Infant wide-field retinal image
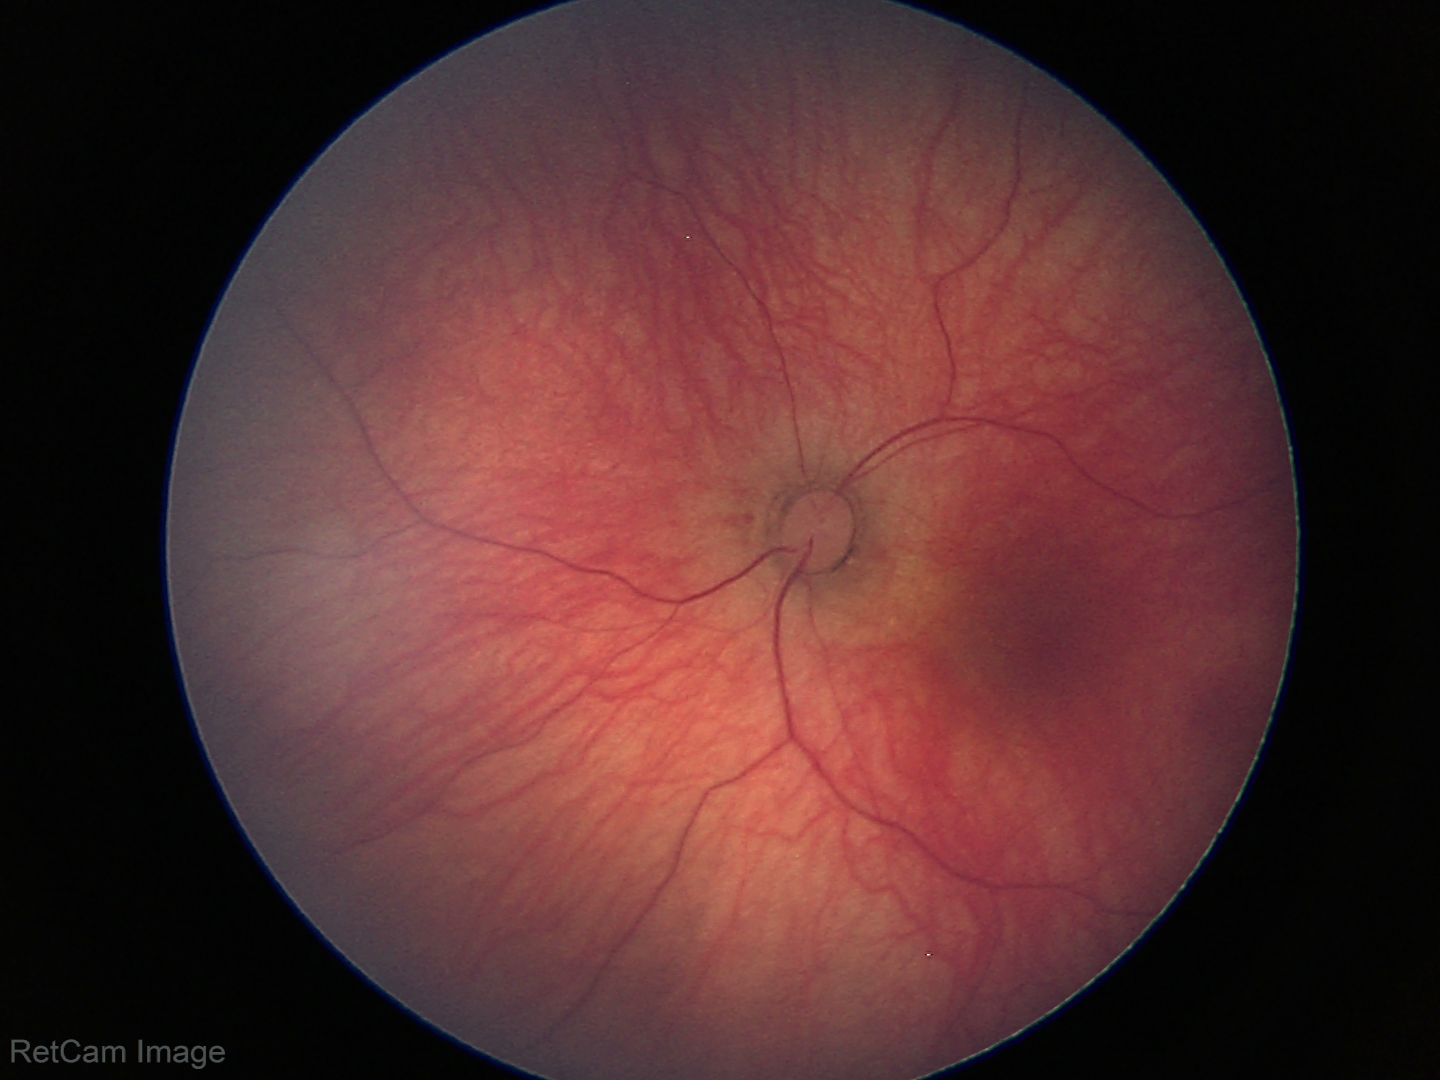
Screening examination diagnosed as physiological.